45° field of view:
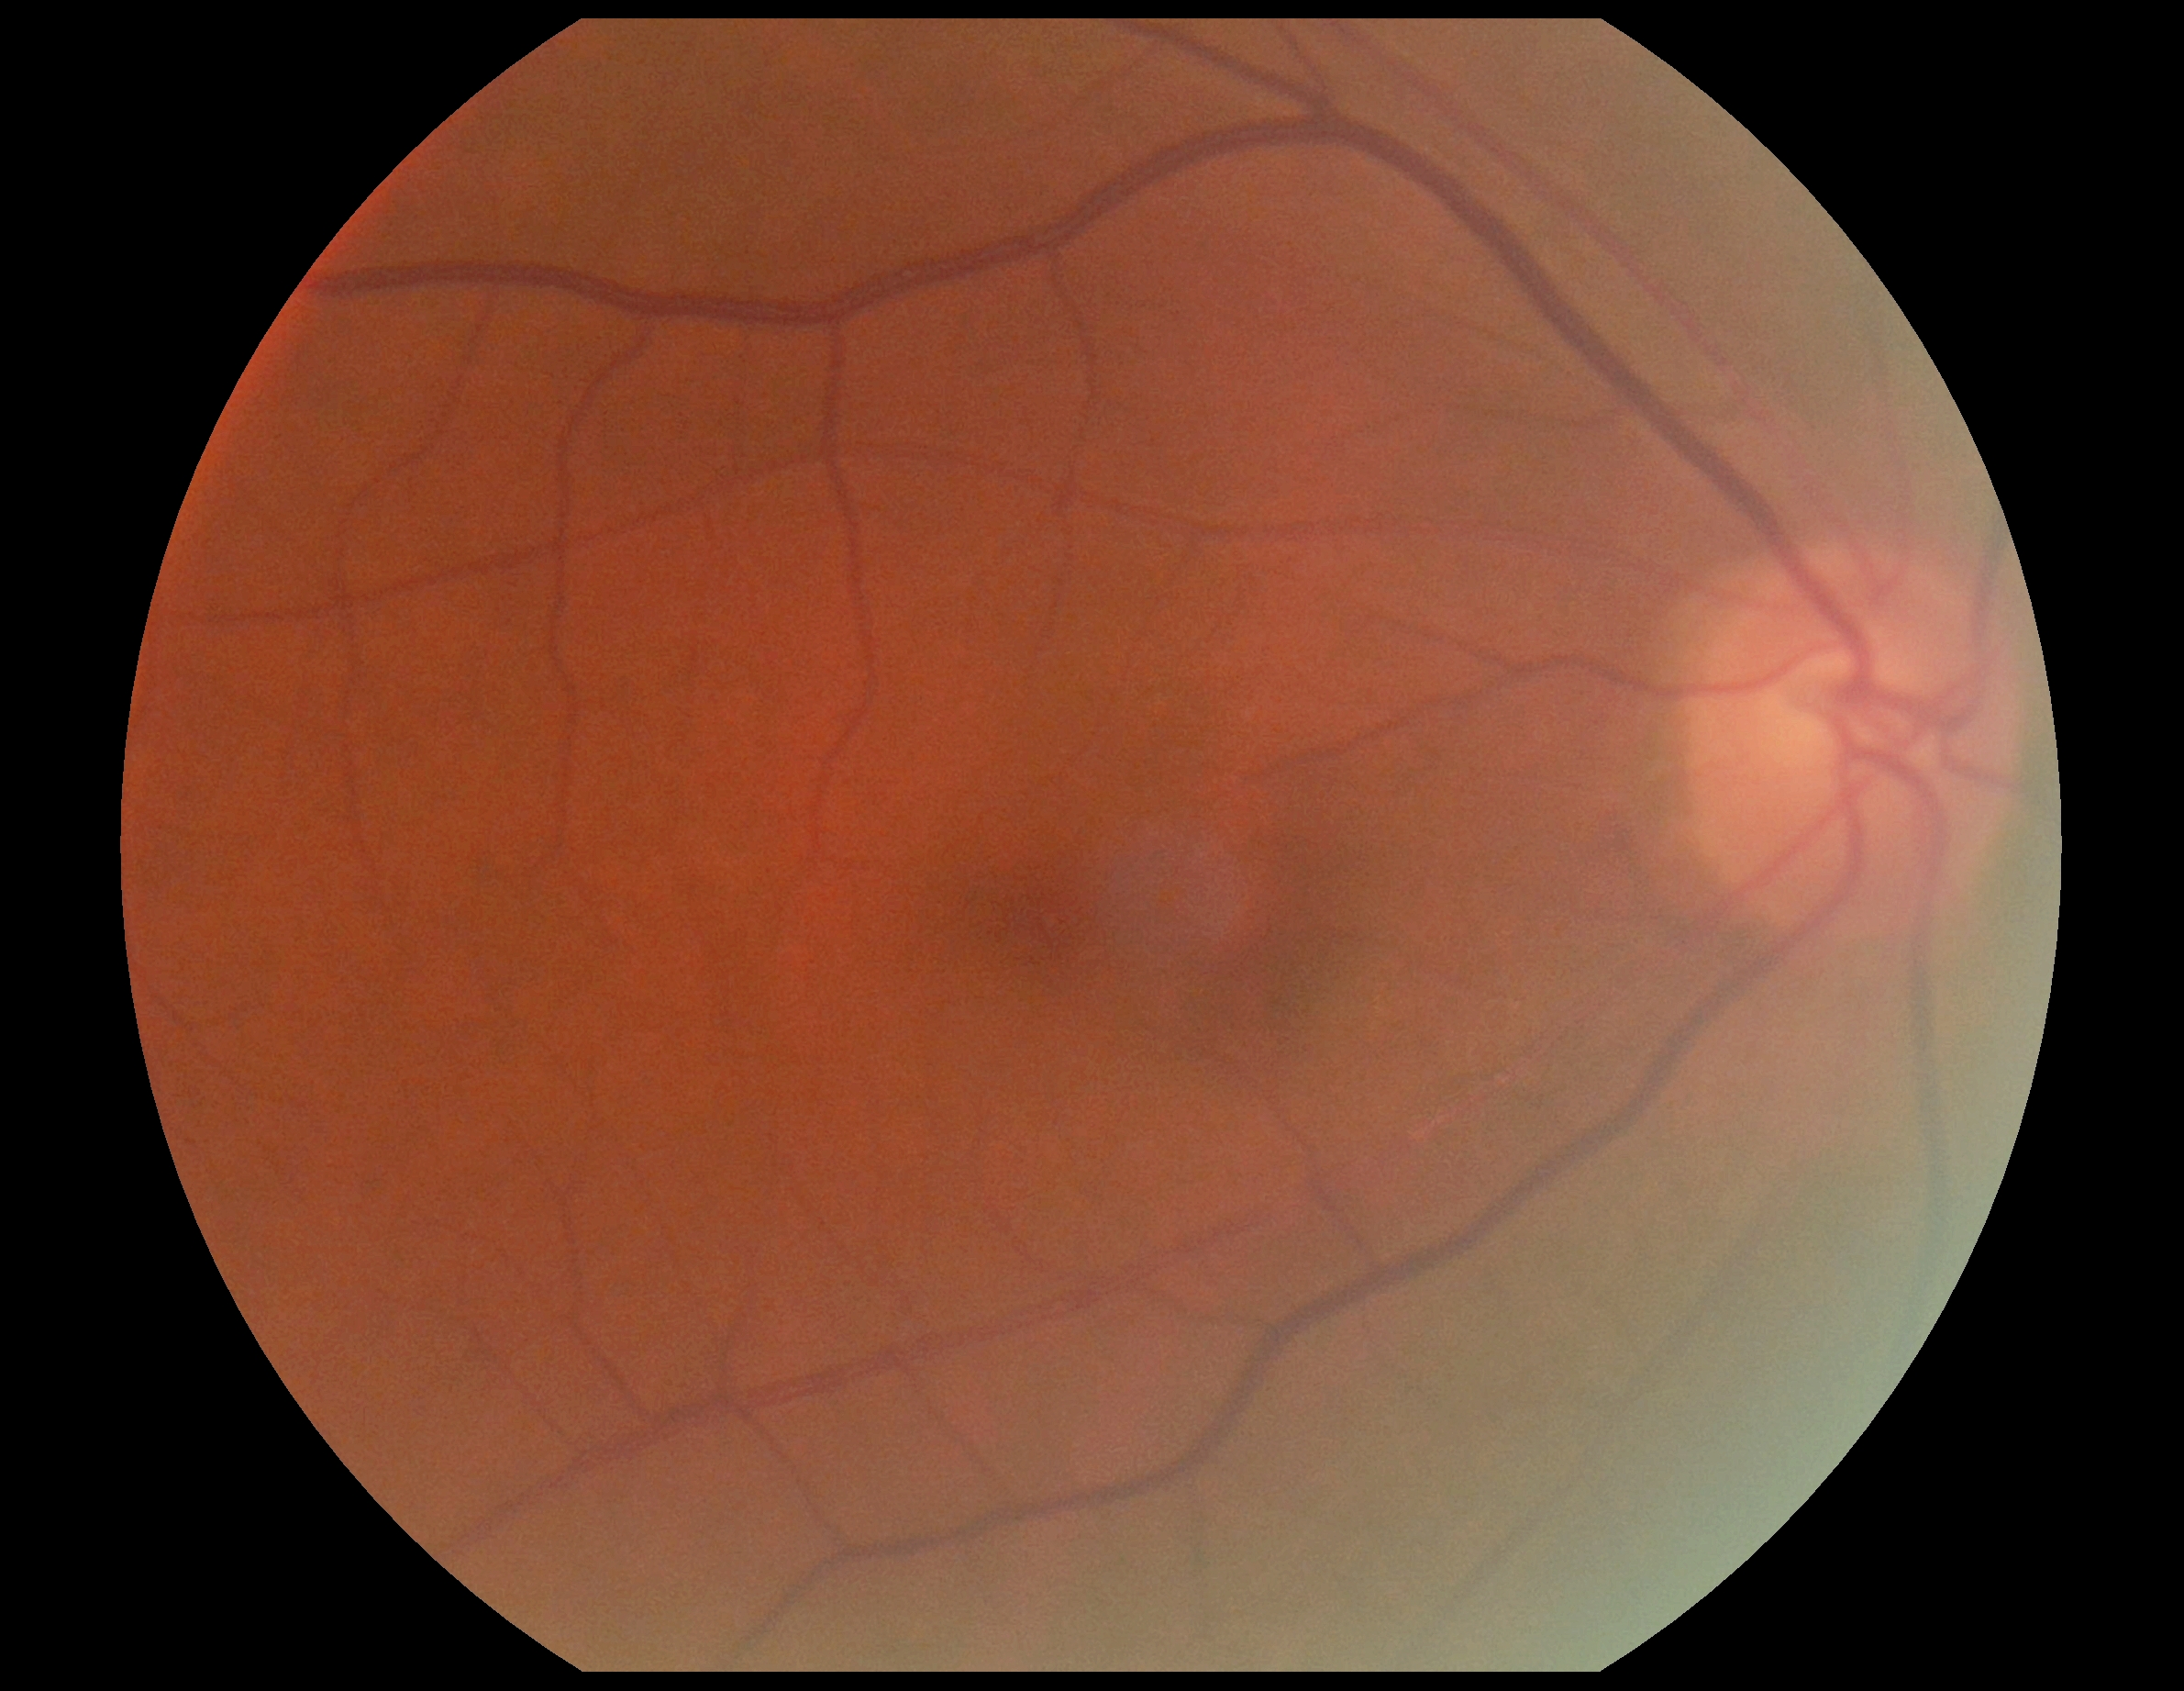
No DR findings.
Diabetic retinopathy (DR): 0/4.